CFP. 2352 x 1568 pixels. 45° field of view
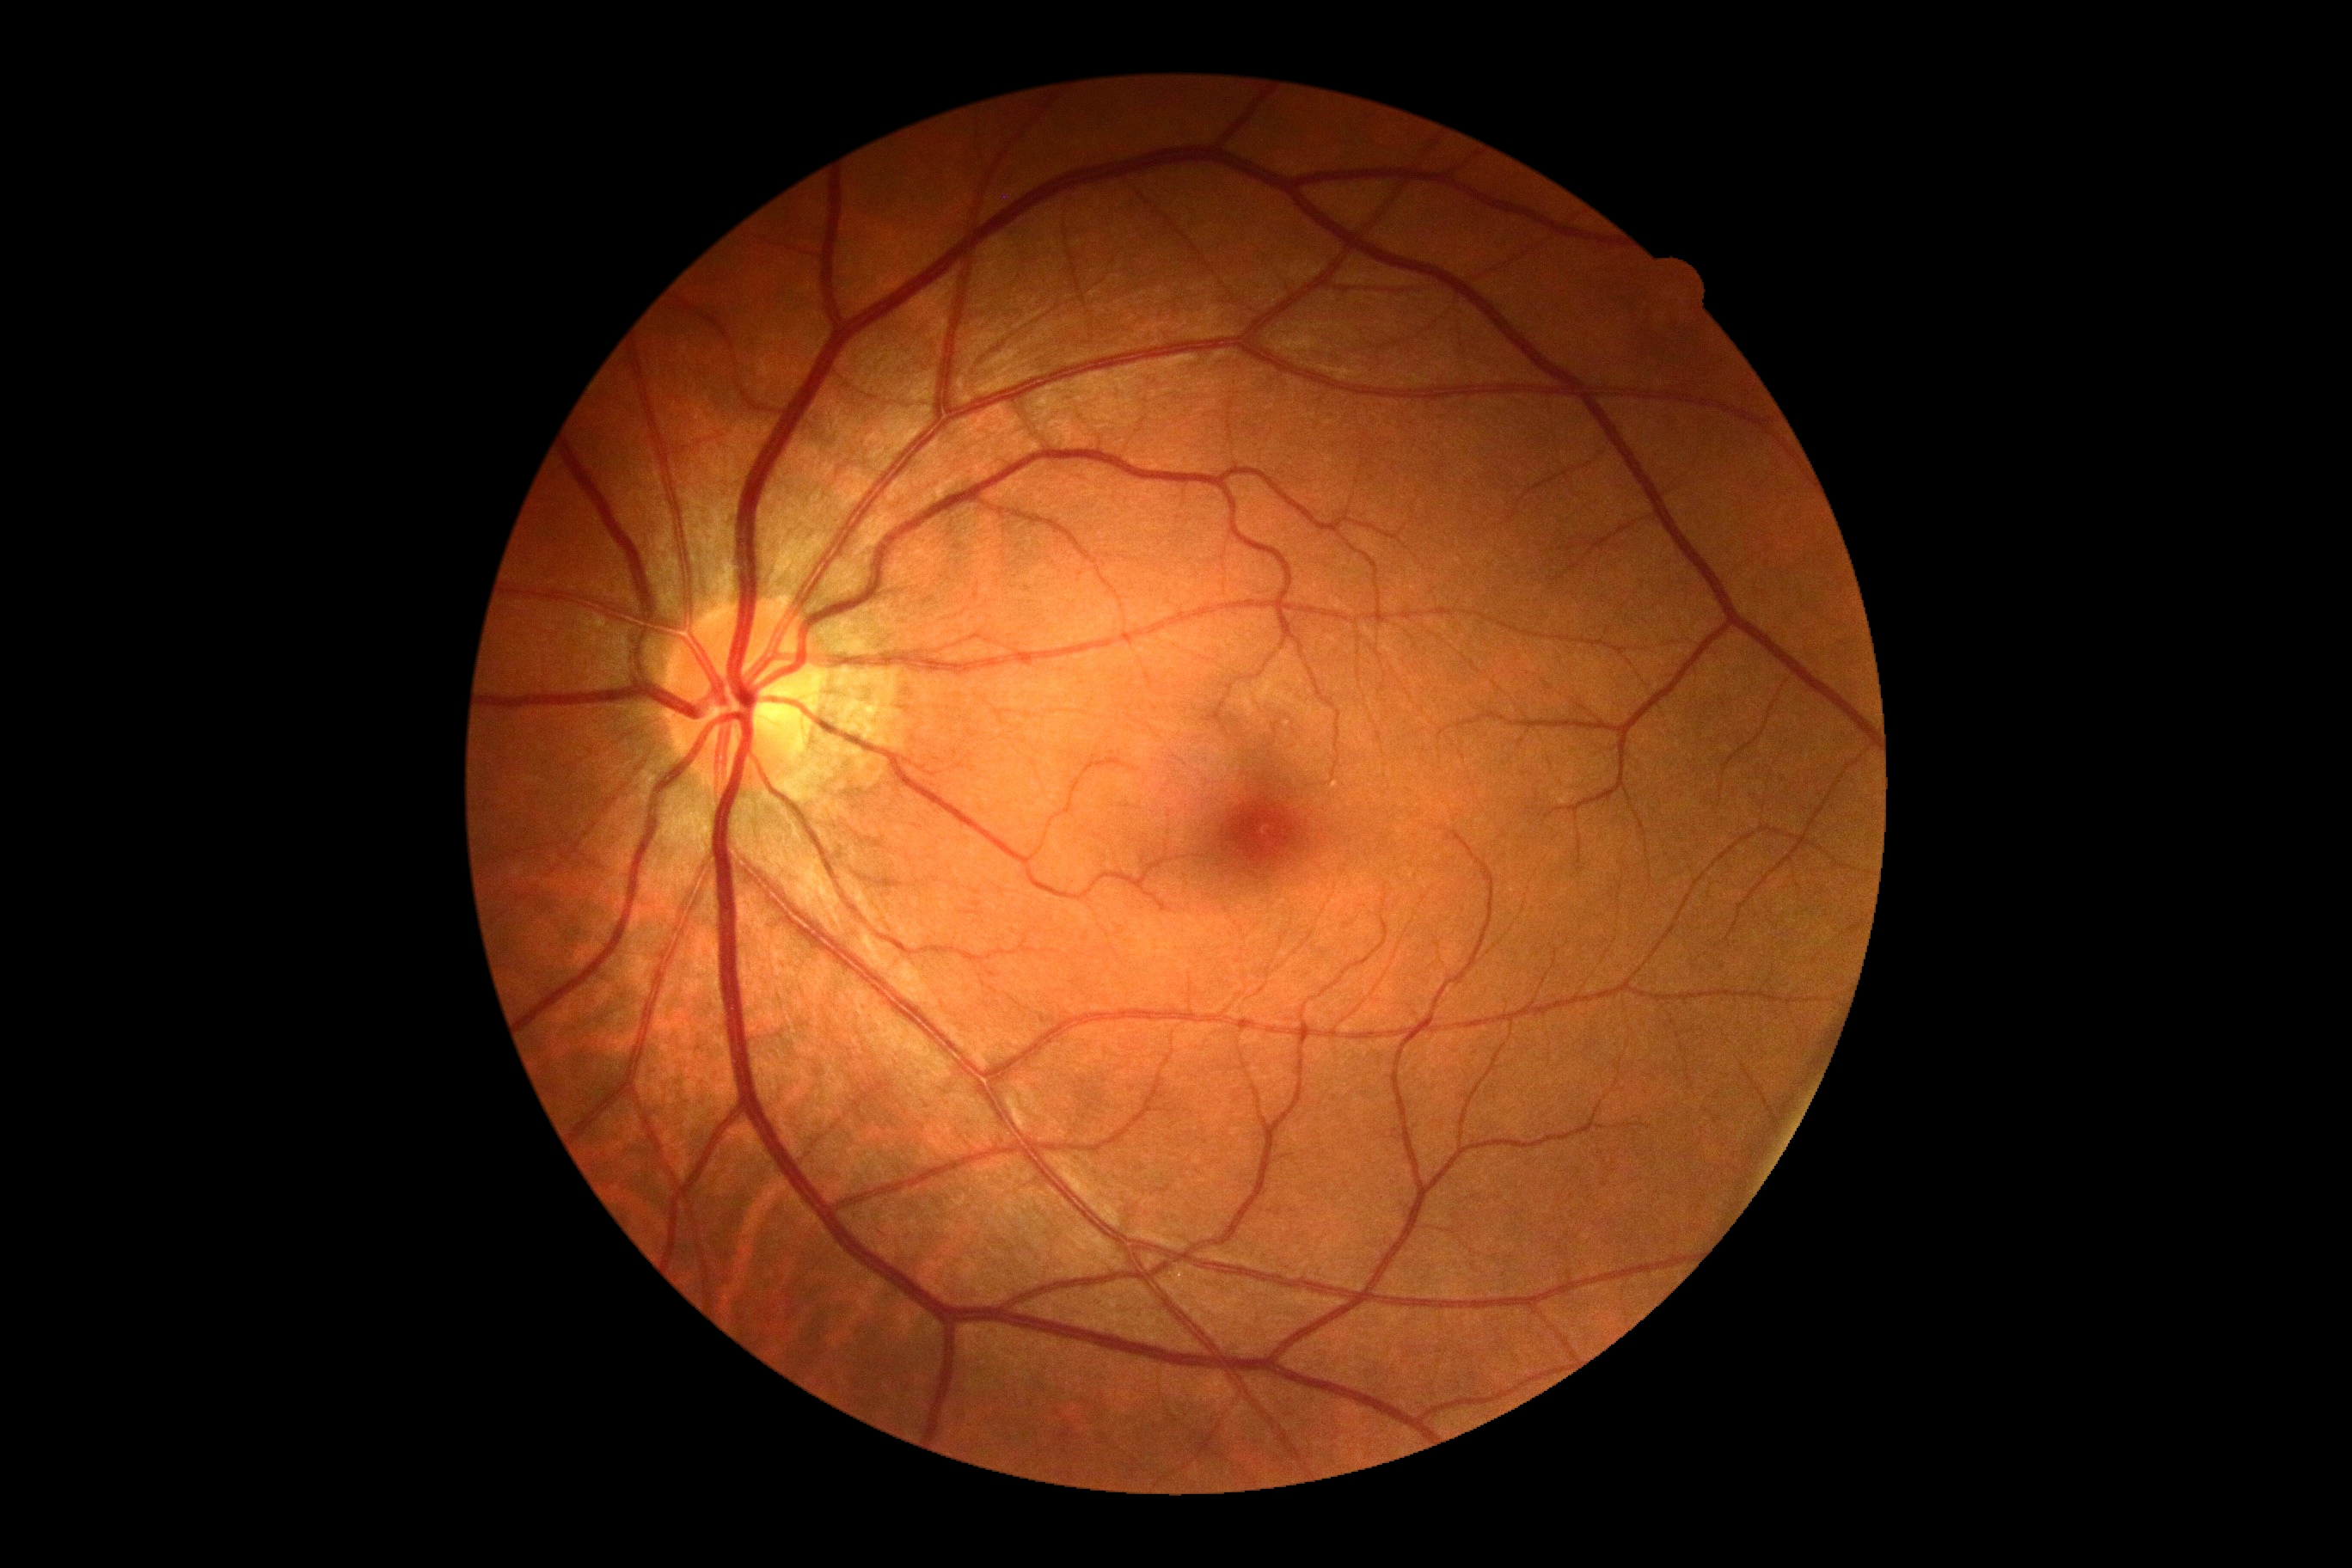
Diabetic retinopathy grade is no apparent retinopathy (0).
No DR findings.